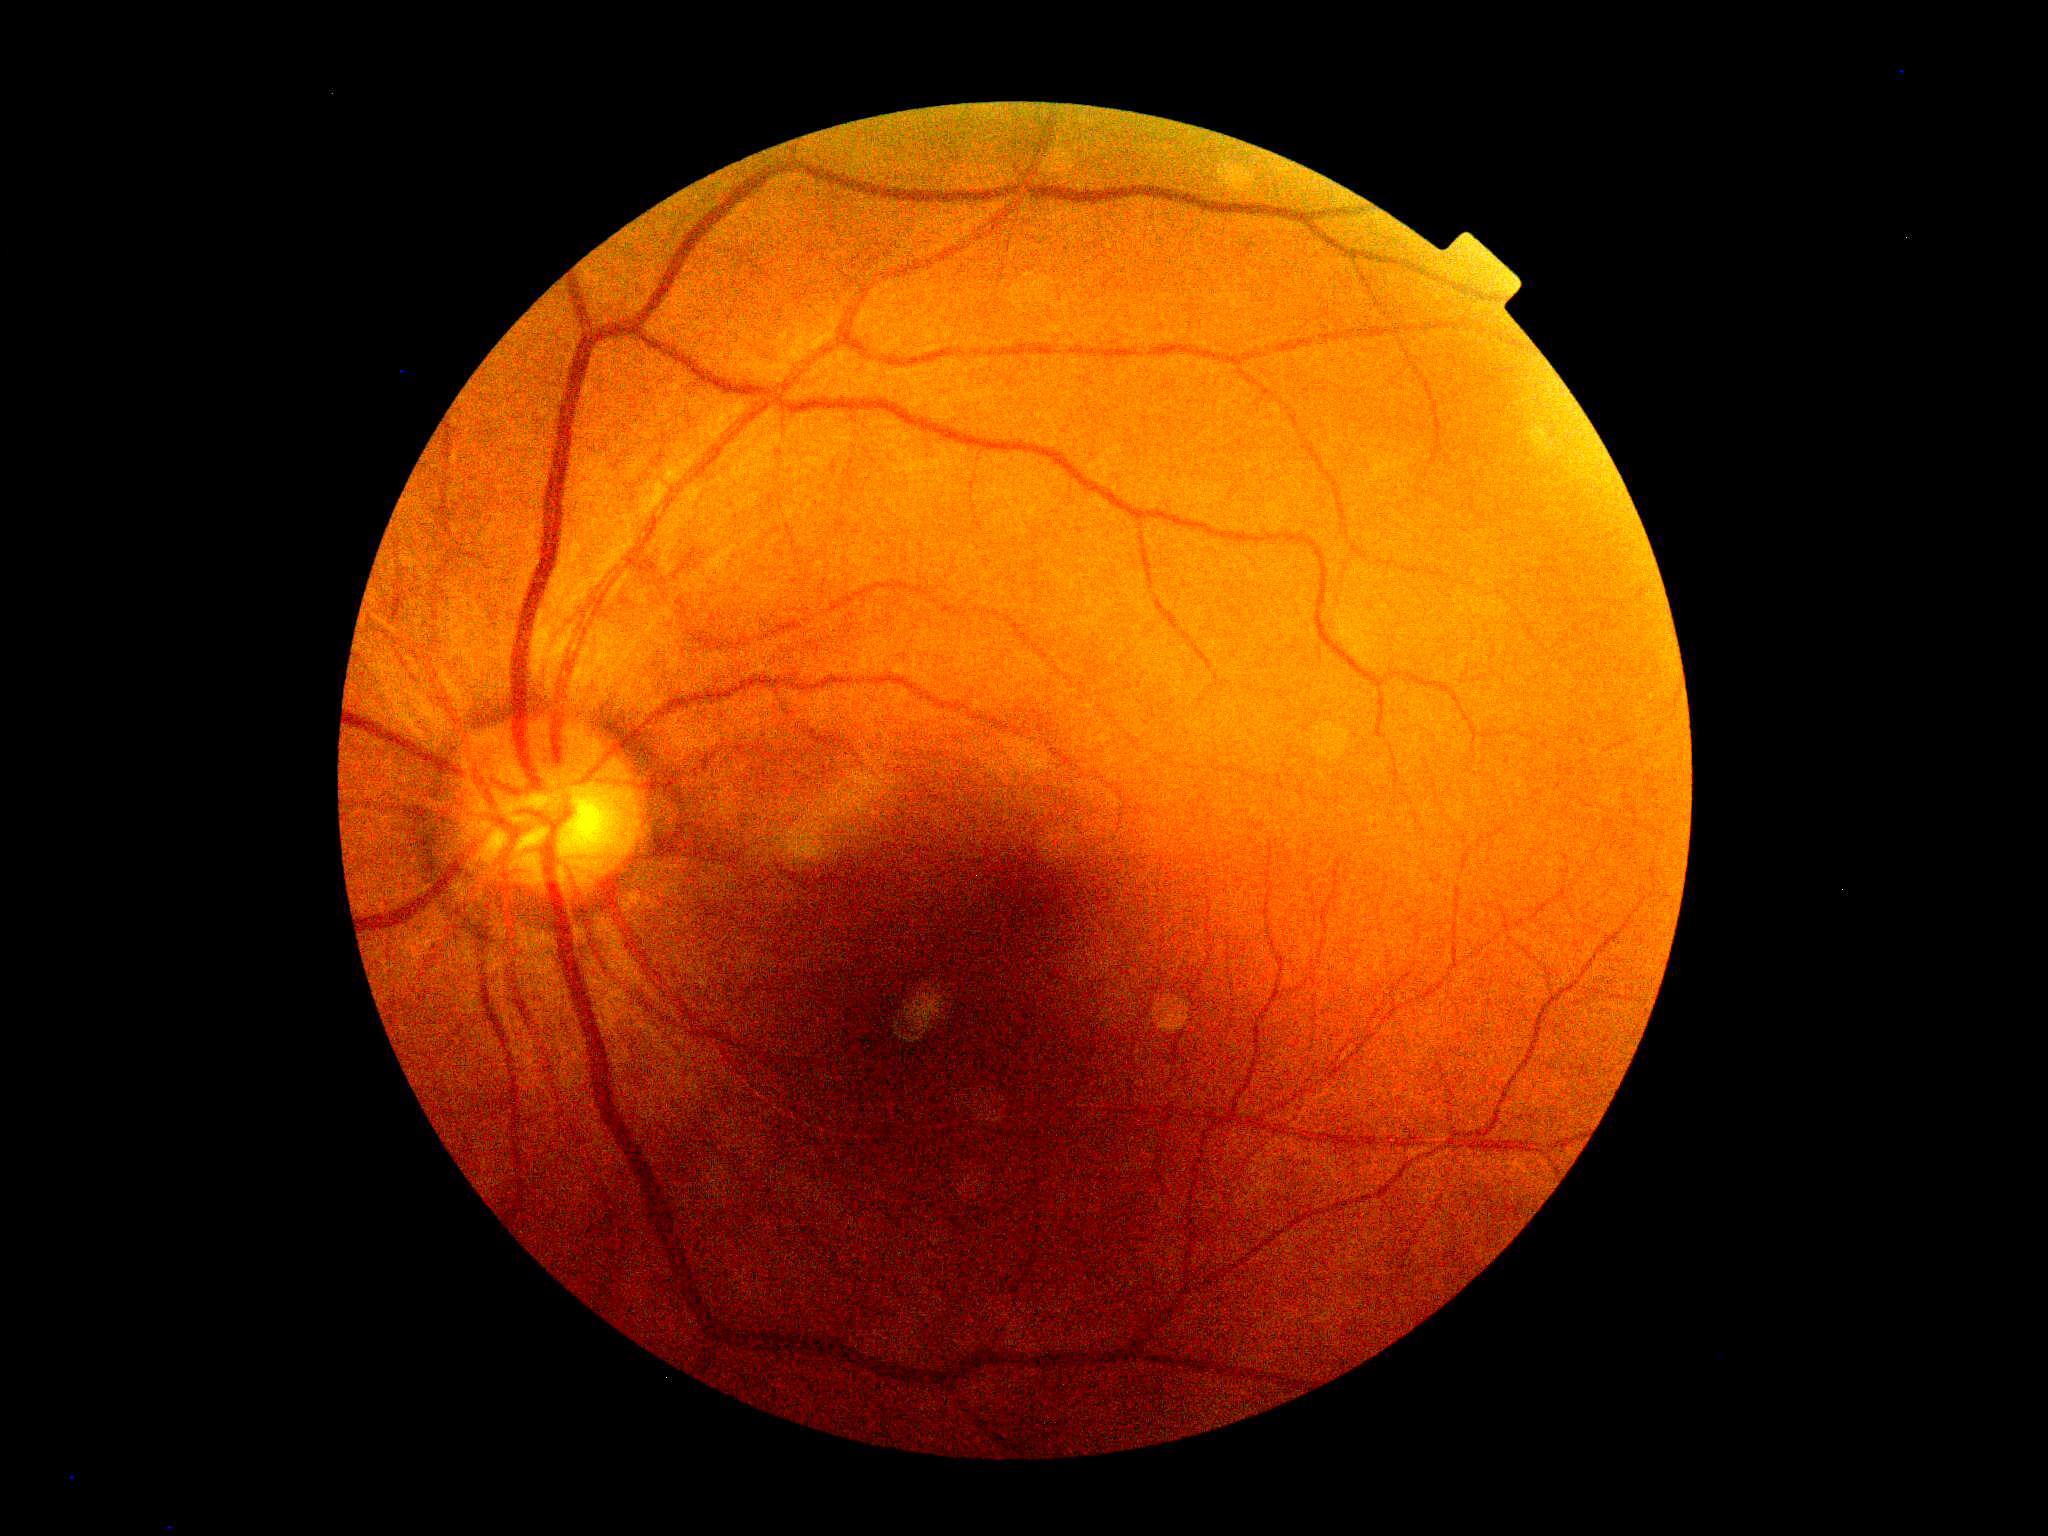

Annotations:
– diabetic retinopathy (DR): 0/4